45° FOV. Color fundus image. Diabetic retinopathy graded by the modified Davis classification:
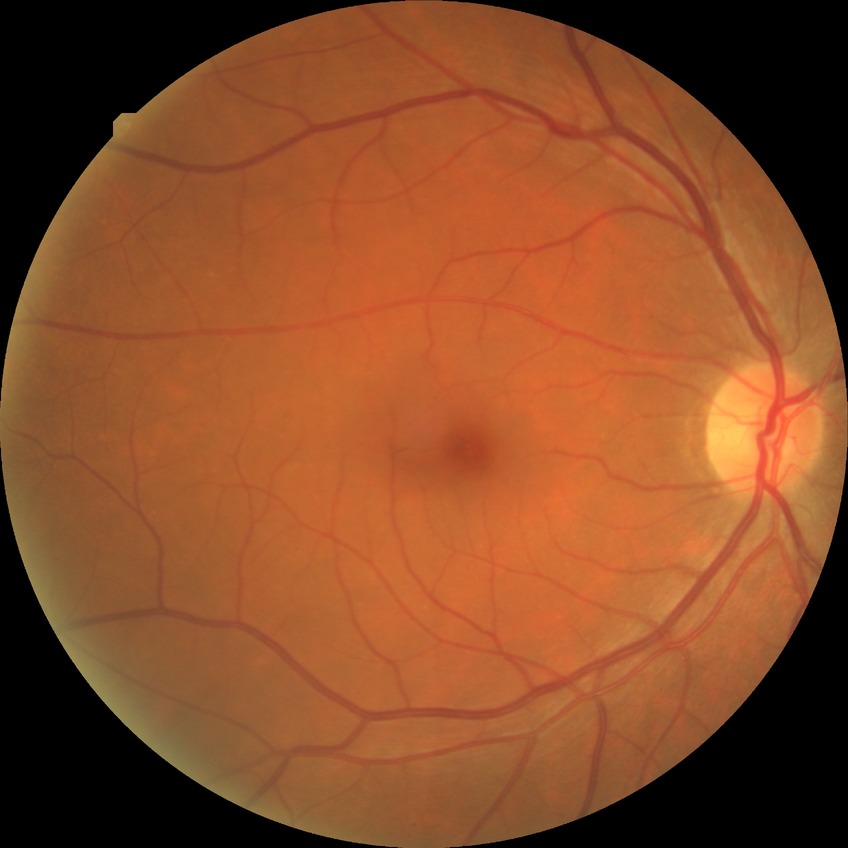
No apparent diabetic retinopathy.
Davis DR grade: NDR.